Infant wide-field retinal image.
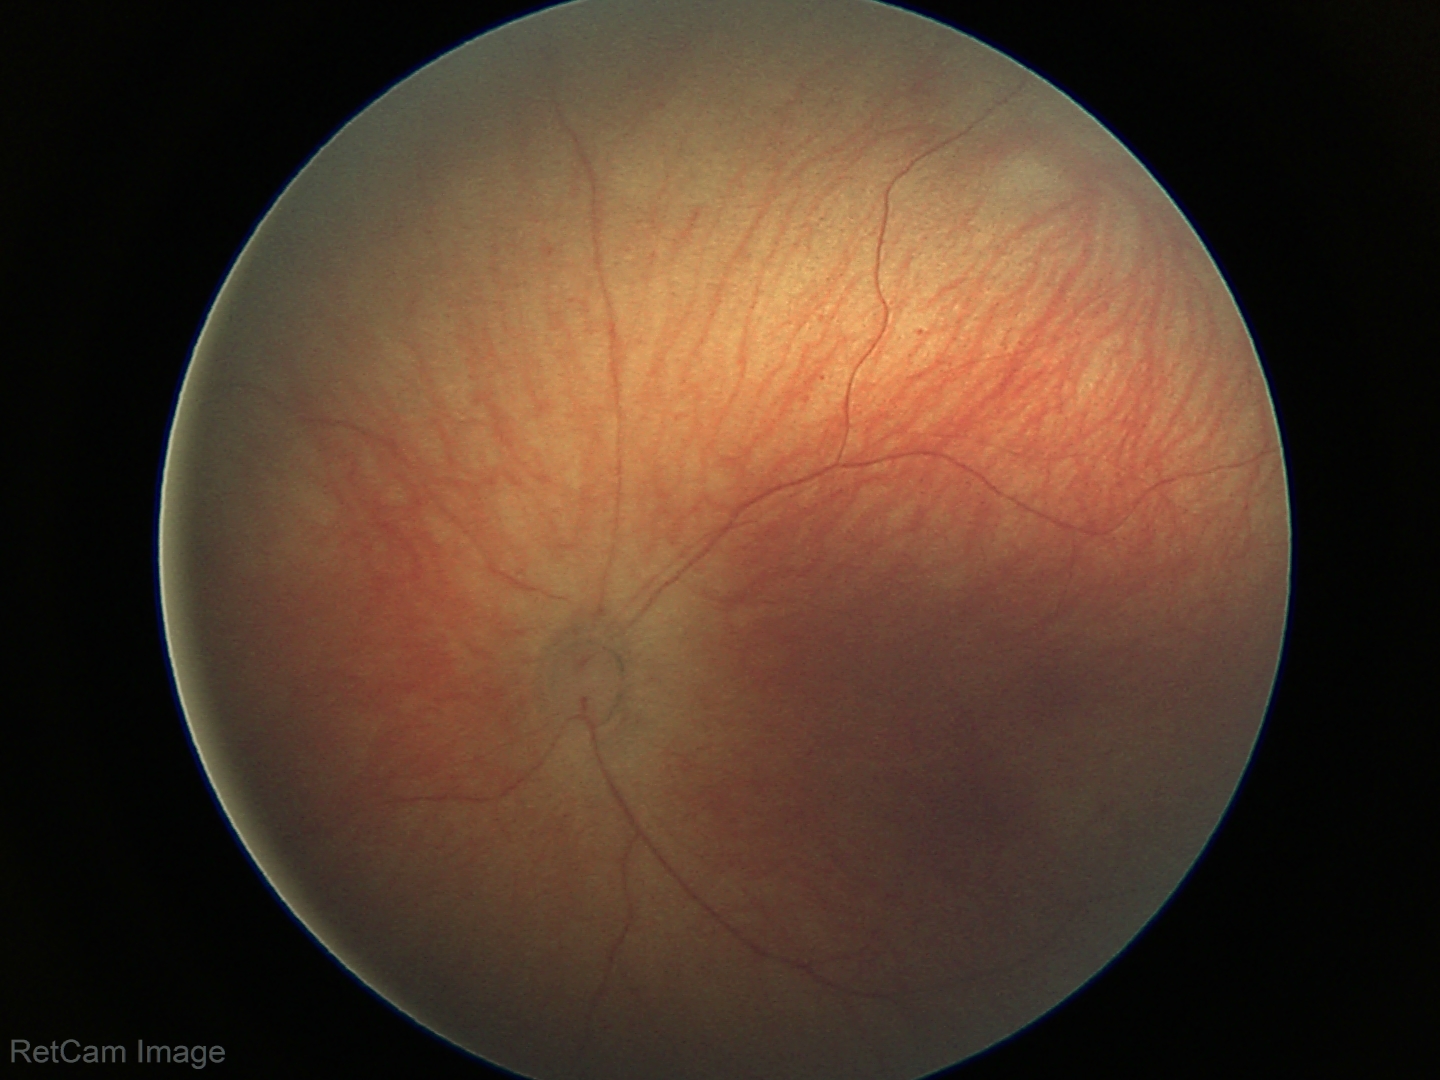

Screening examination diagnosed as physiological.